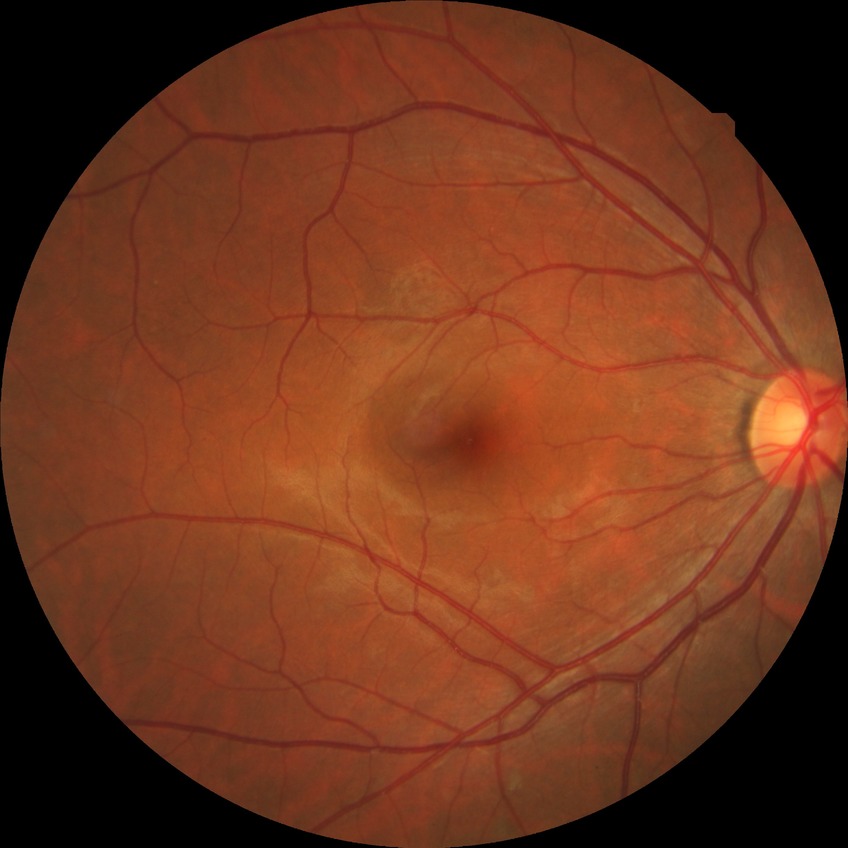 Diabetic retinopathy (DR) is simple diabetic retinopathy (SDR).